Nonmydriatic, 45-degree field of view:
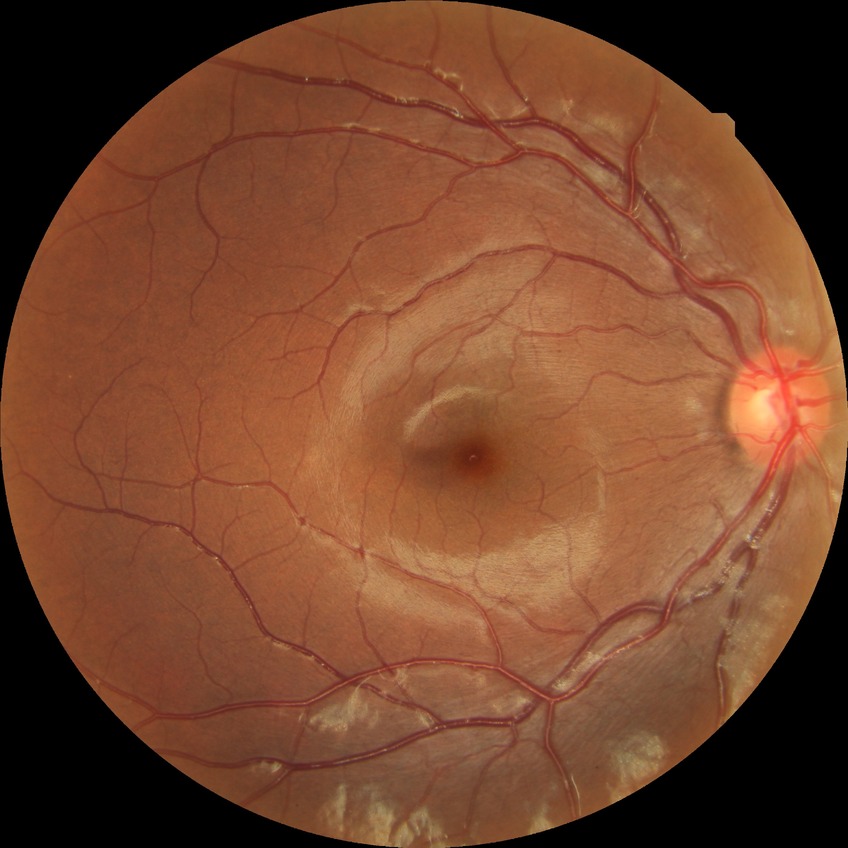 DR: SDR.